763x724px.
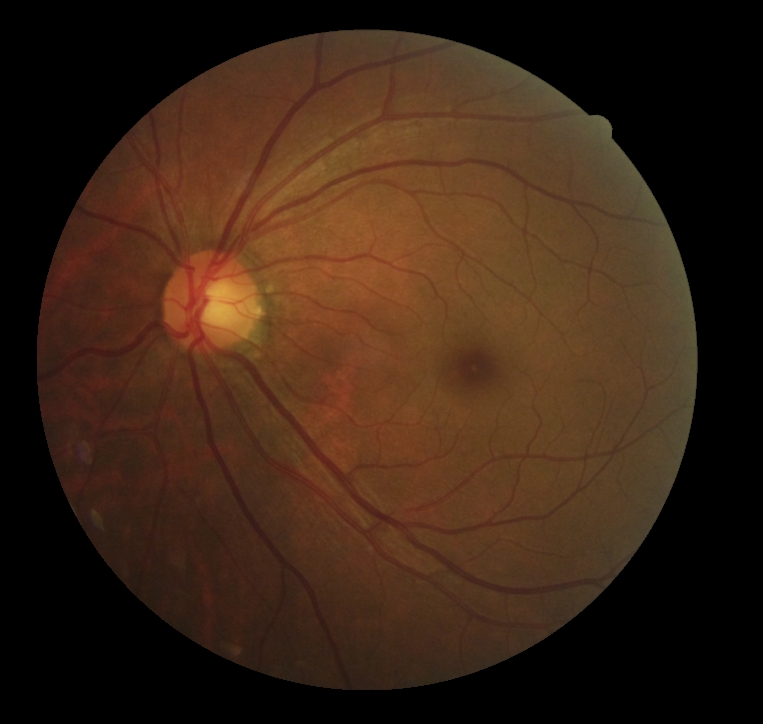

DR impression: no signs of DR | diabetic retinopathy: no apparent retinopathy (grade 0) — no visible signs of diabetic retinopathy.